Acquired with a Topcon TRC · ONH-centered crop from a color fundus image.
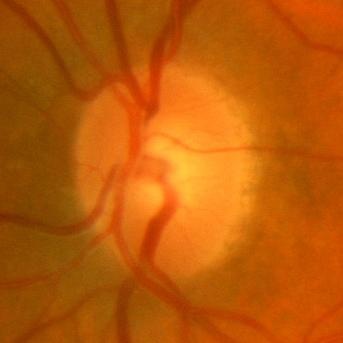

No glaucoma.